Phoenix ICON wide-field infant fundus image — 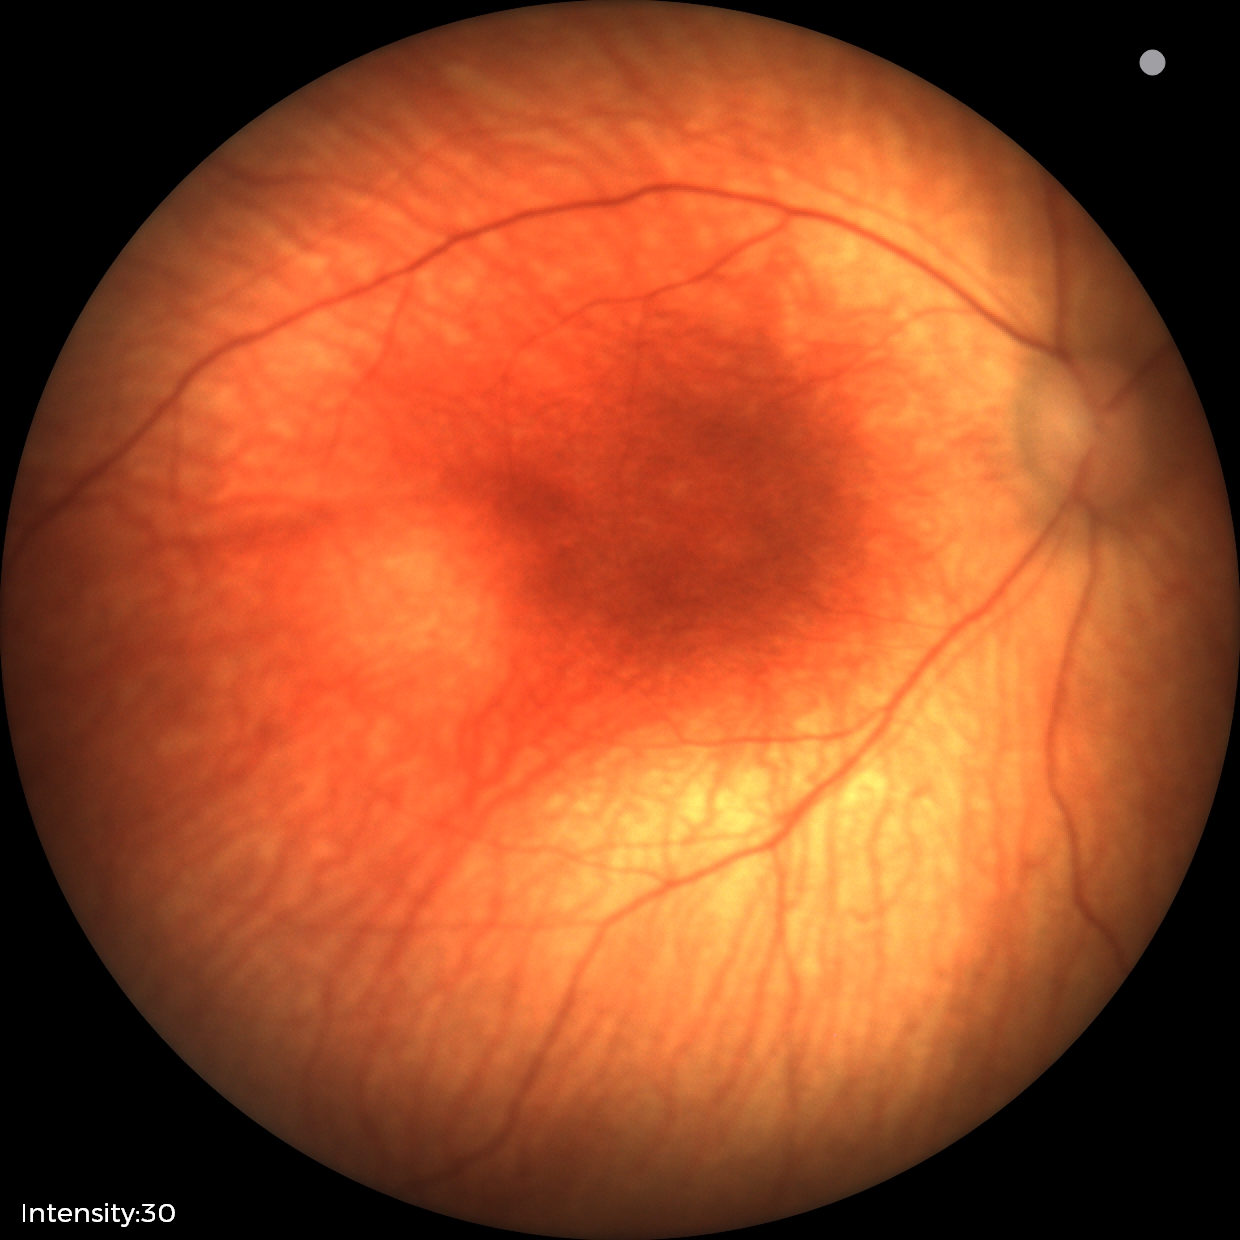

Screening examination with no abnormal retinal findings.